Wide-field fundus photograph of an infant. 1440 by 1080 pixels:
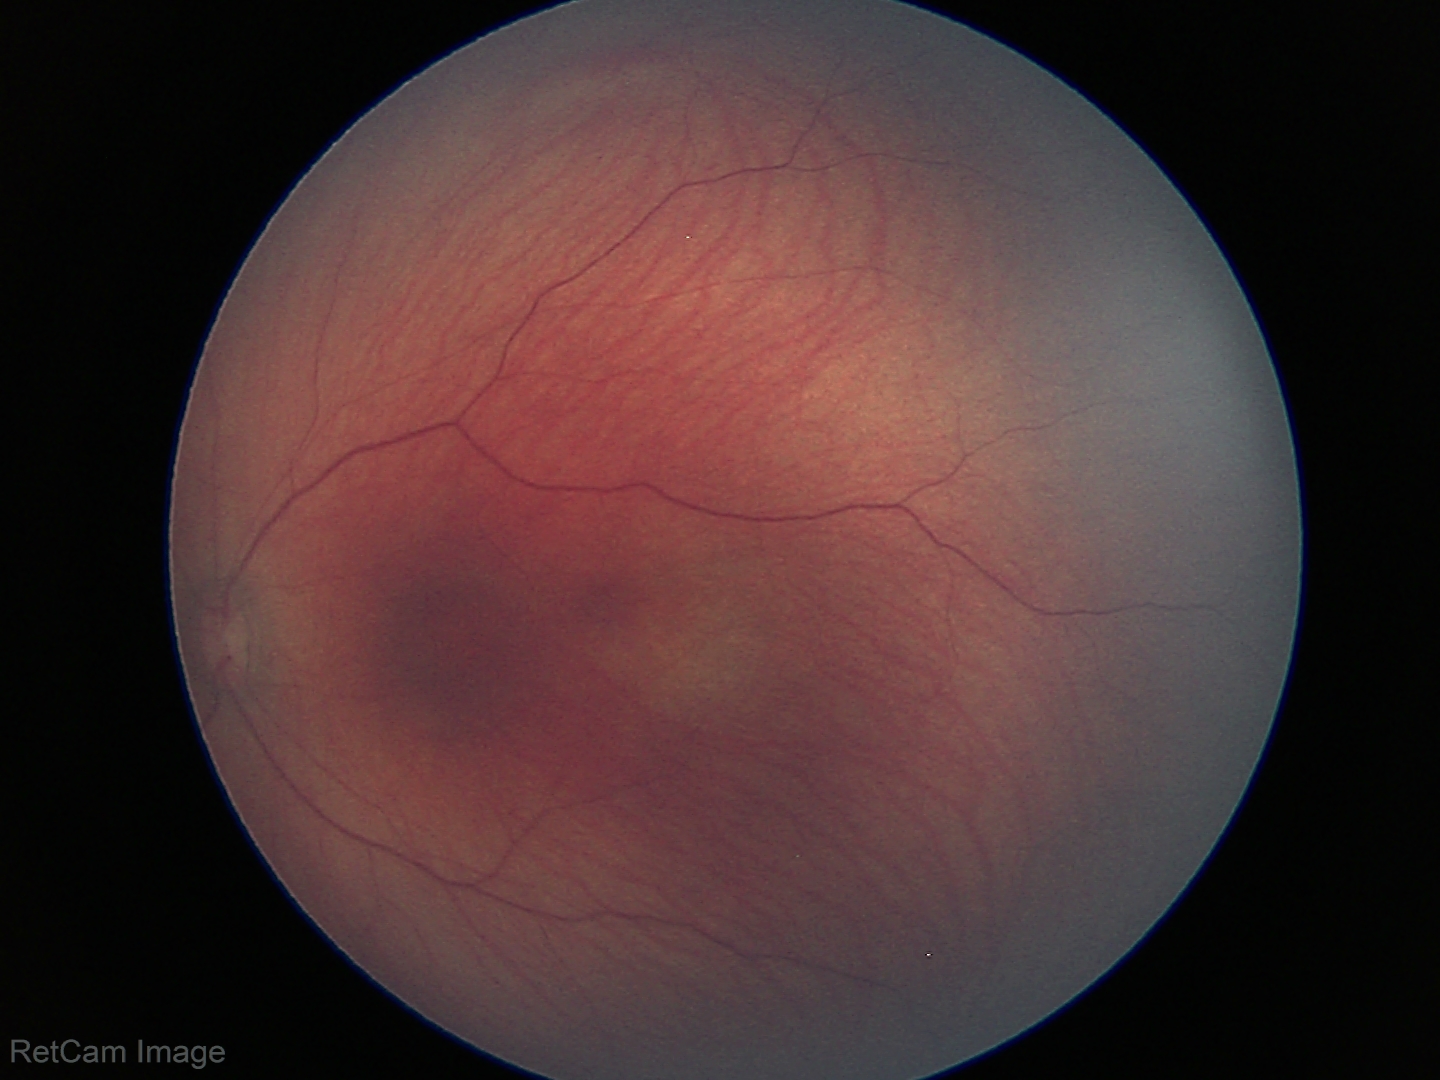

Impression = no abnormalities.